Fundus image cropped to the optic disc; cropped from a 35-degree field of view
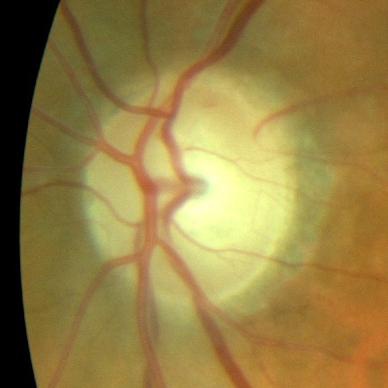

There is evidence of no glaucomatous findings.